Camera: Phoenix ICON (100° FOV). Image size 1240x1240. Phoenix ICON wide-field infant fundus image: 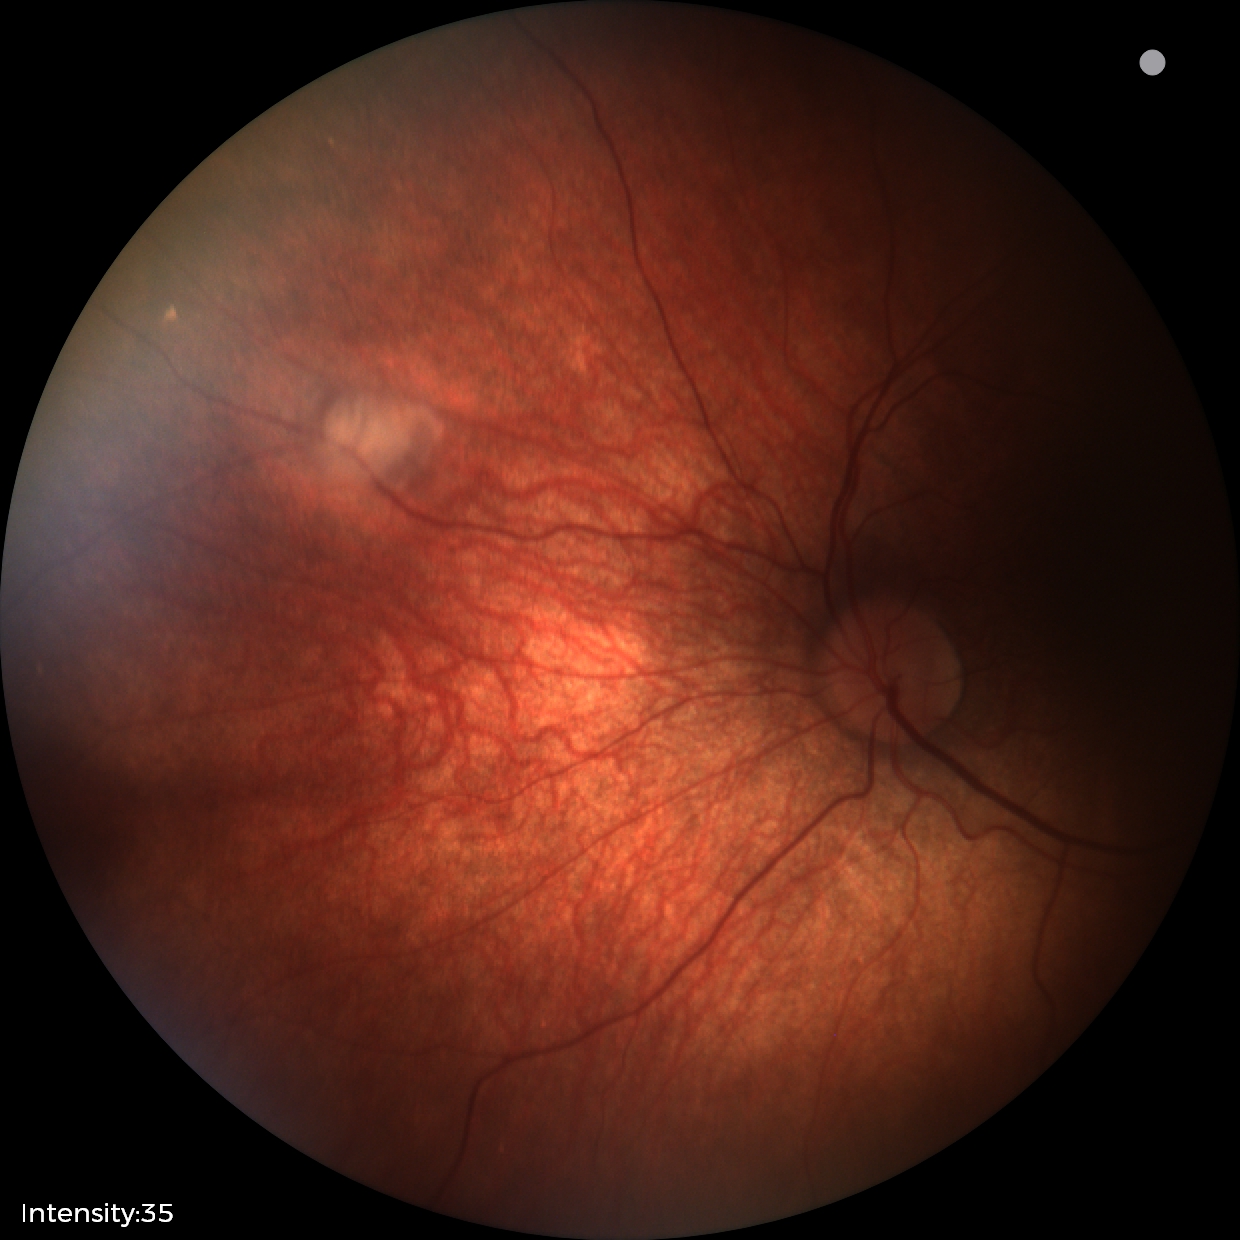

Screening: retinal astrocytic hamartoma.